Retinal fundus photograph, FOV: 45 degrees
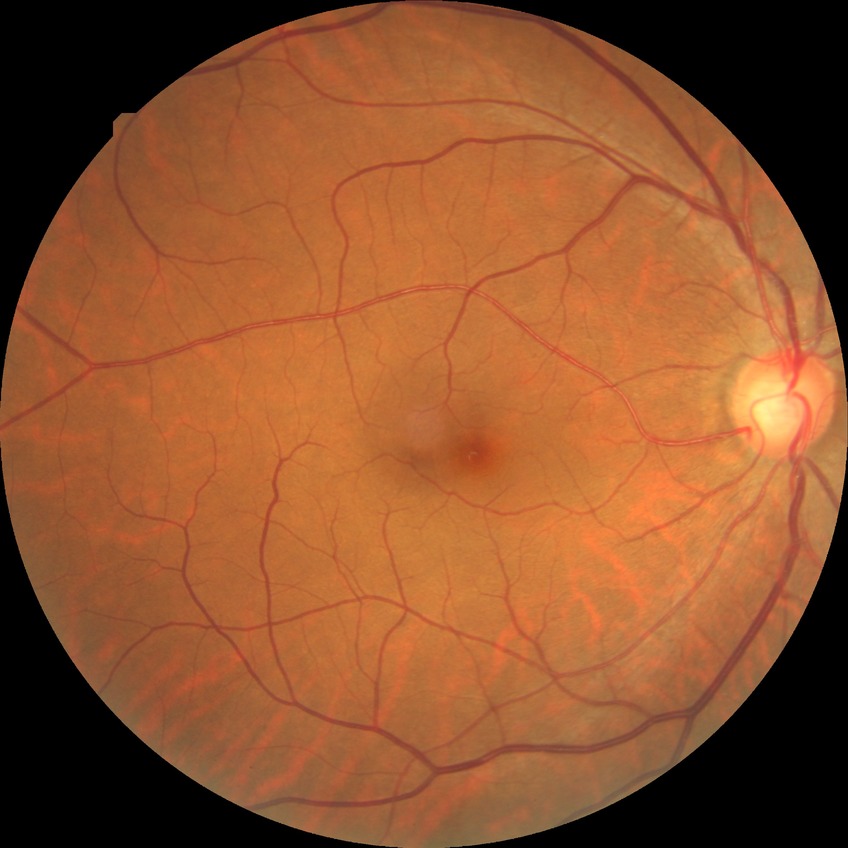

diabetic retinopathy grade = no diabetic retinopathy